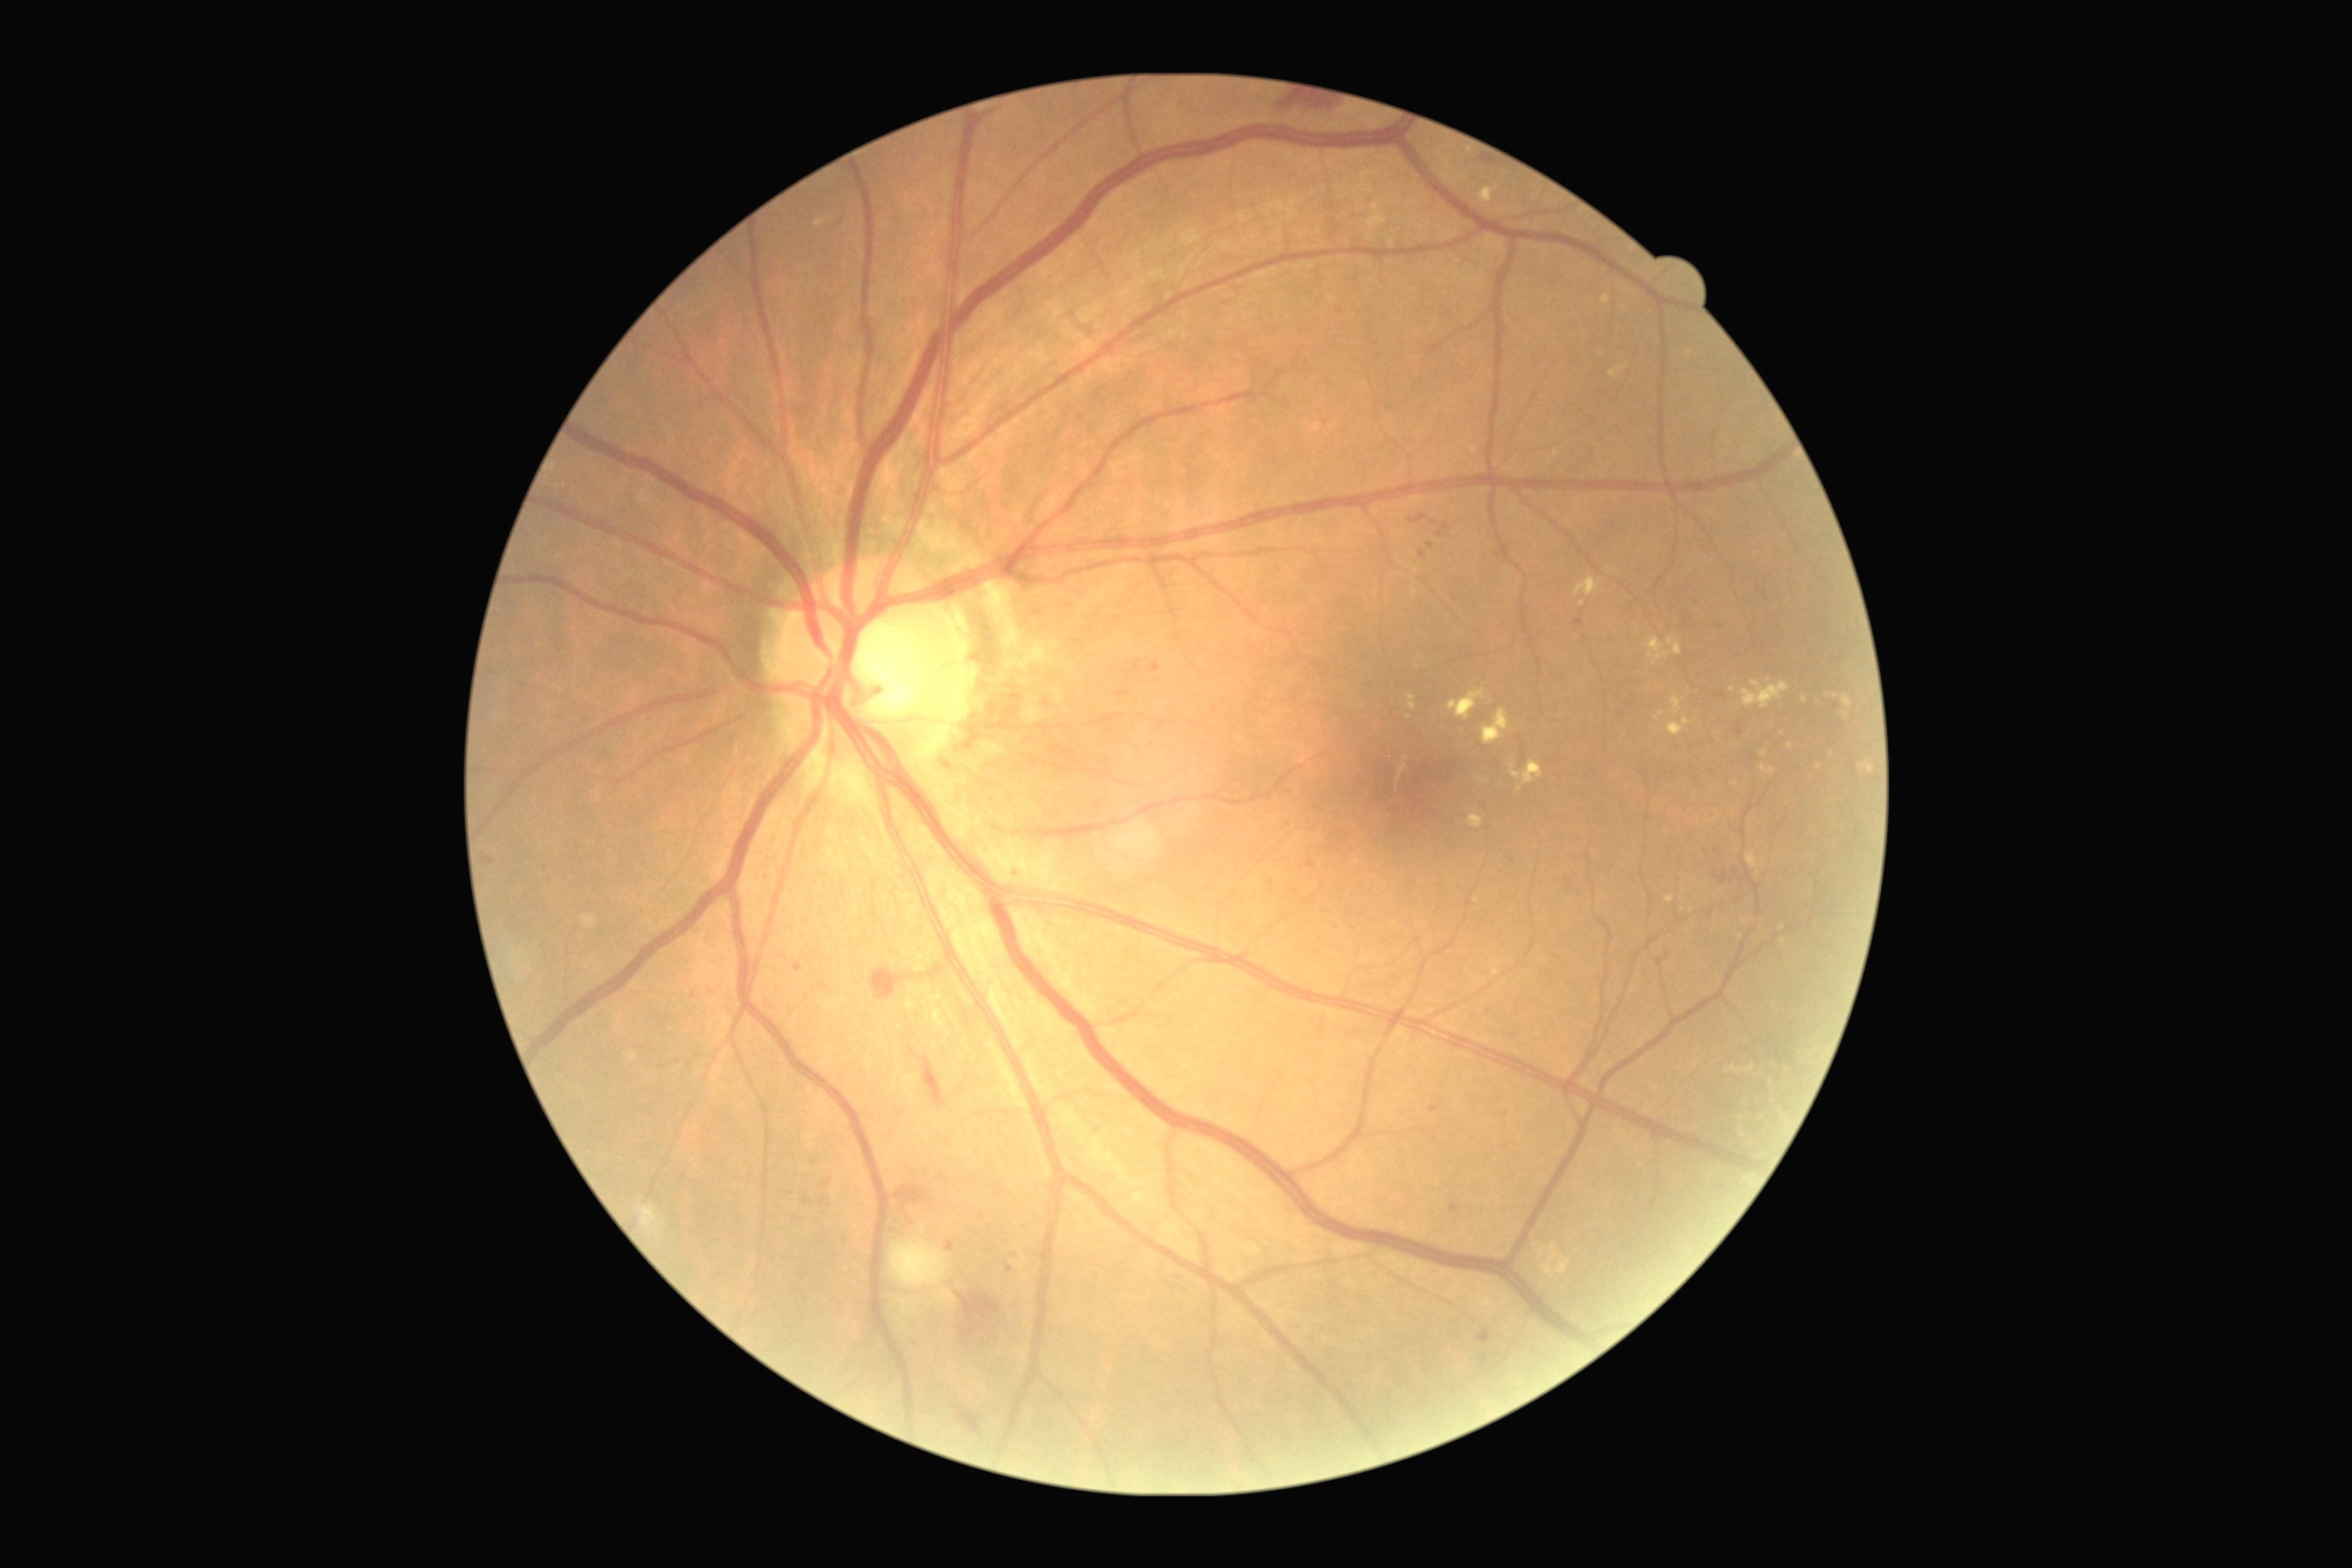 partial: true
dr_grade: 2
lesions:
  he:
    - rect(954, 1406, 983, 1435)
    - rect(1482, 159, 1494, 166)
    - rect(957, 1293, 1001, 1324)
    - rect(925, 1057, 946, 1110)
    - rect(872, 968, 901, 999)
    - rect(968, 1322, 977, 1335)
    - rect(1667, 950, 1672, 959)
    - rect(1289, 97, 1333, 112)
    - rect(897, 1188, 925, 1202)
  he_small_centers:
    - <point>964, 1332</point>
    - <point>1659, 962</point>
  ex:
    - rect(816, 219, 828, 228)
    - rect(1482, 709, 1509, 745)
    - rect(1647, 636, 1671, 665)
    - rect(1665, 896, 1674, 903)
    - rect(1576, 578, 1600, 598)
    - rect(1667, 638, 1683, 656)
    - rect(1407, 694, 1416, 710)
    - rect(1741, 681, 1790, 710)
  ex_small_centers:
    - <point>1409, 718</point>
    - <point>1733, 690</point>
    - <point>1770, 679</point>
  se:
    - rect(890, 1240, 950, 1289)
  ma:
    - rect(1736, 725, 1745, 736)
    - rect(484, 856, 495, 865)
    - rect(1431, 1106, 1440, 1113)
    - rect(1409, 514, 1427, 524)
    - rect(821, 1197, 830, 1206)
    - rect(1133, 662, 1144, 674)
    - rect(948, 1242, 954, 1251)
    - rect(1476, 1329, 1493, 1344)
    - rect(1732, 867, 1740, 876)
  ma_small_centers:
    - <point>1484, 1360</point>
    - <point>1271, 883</point>
    - <point>1454, 1209</point>
    - <point>1435, 523</point>
    - <point>1311, 864</point>